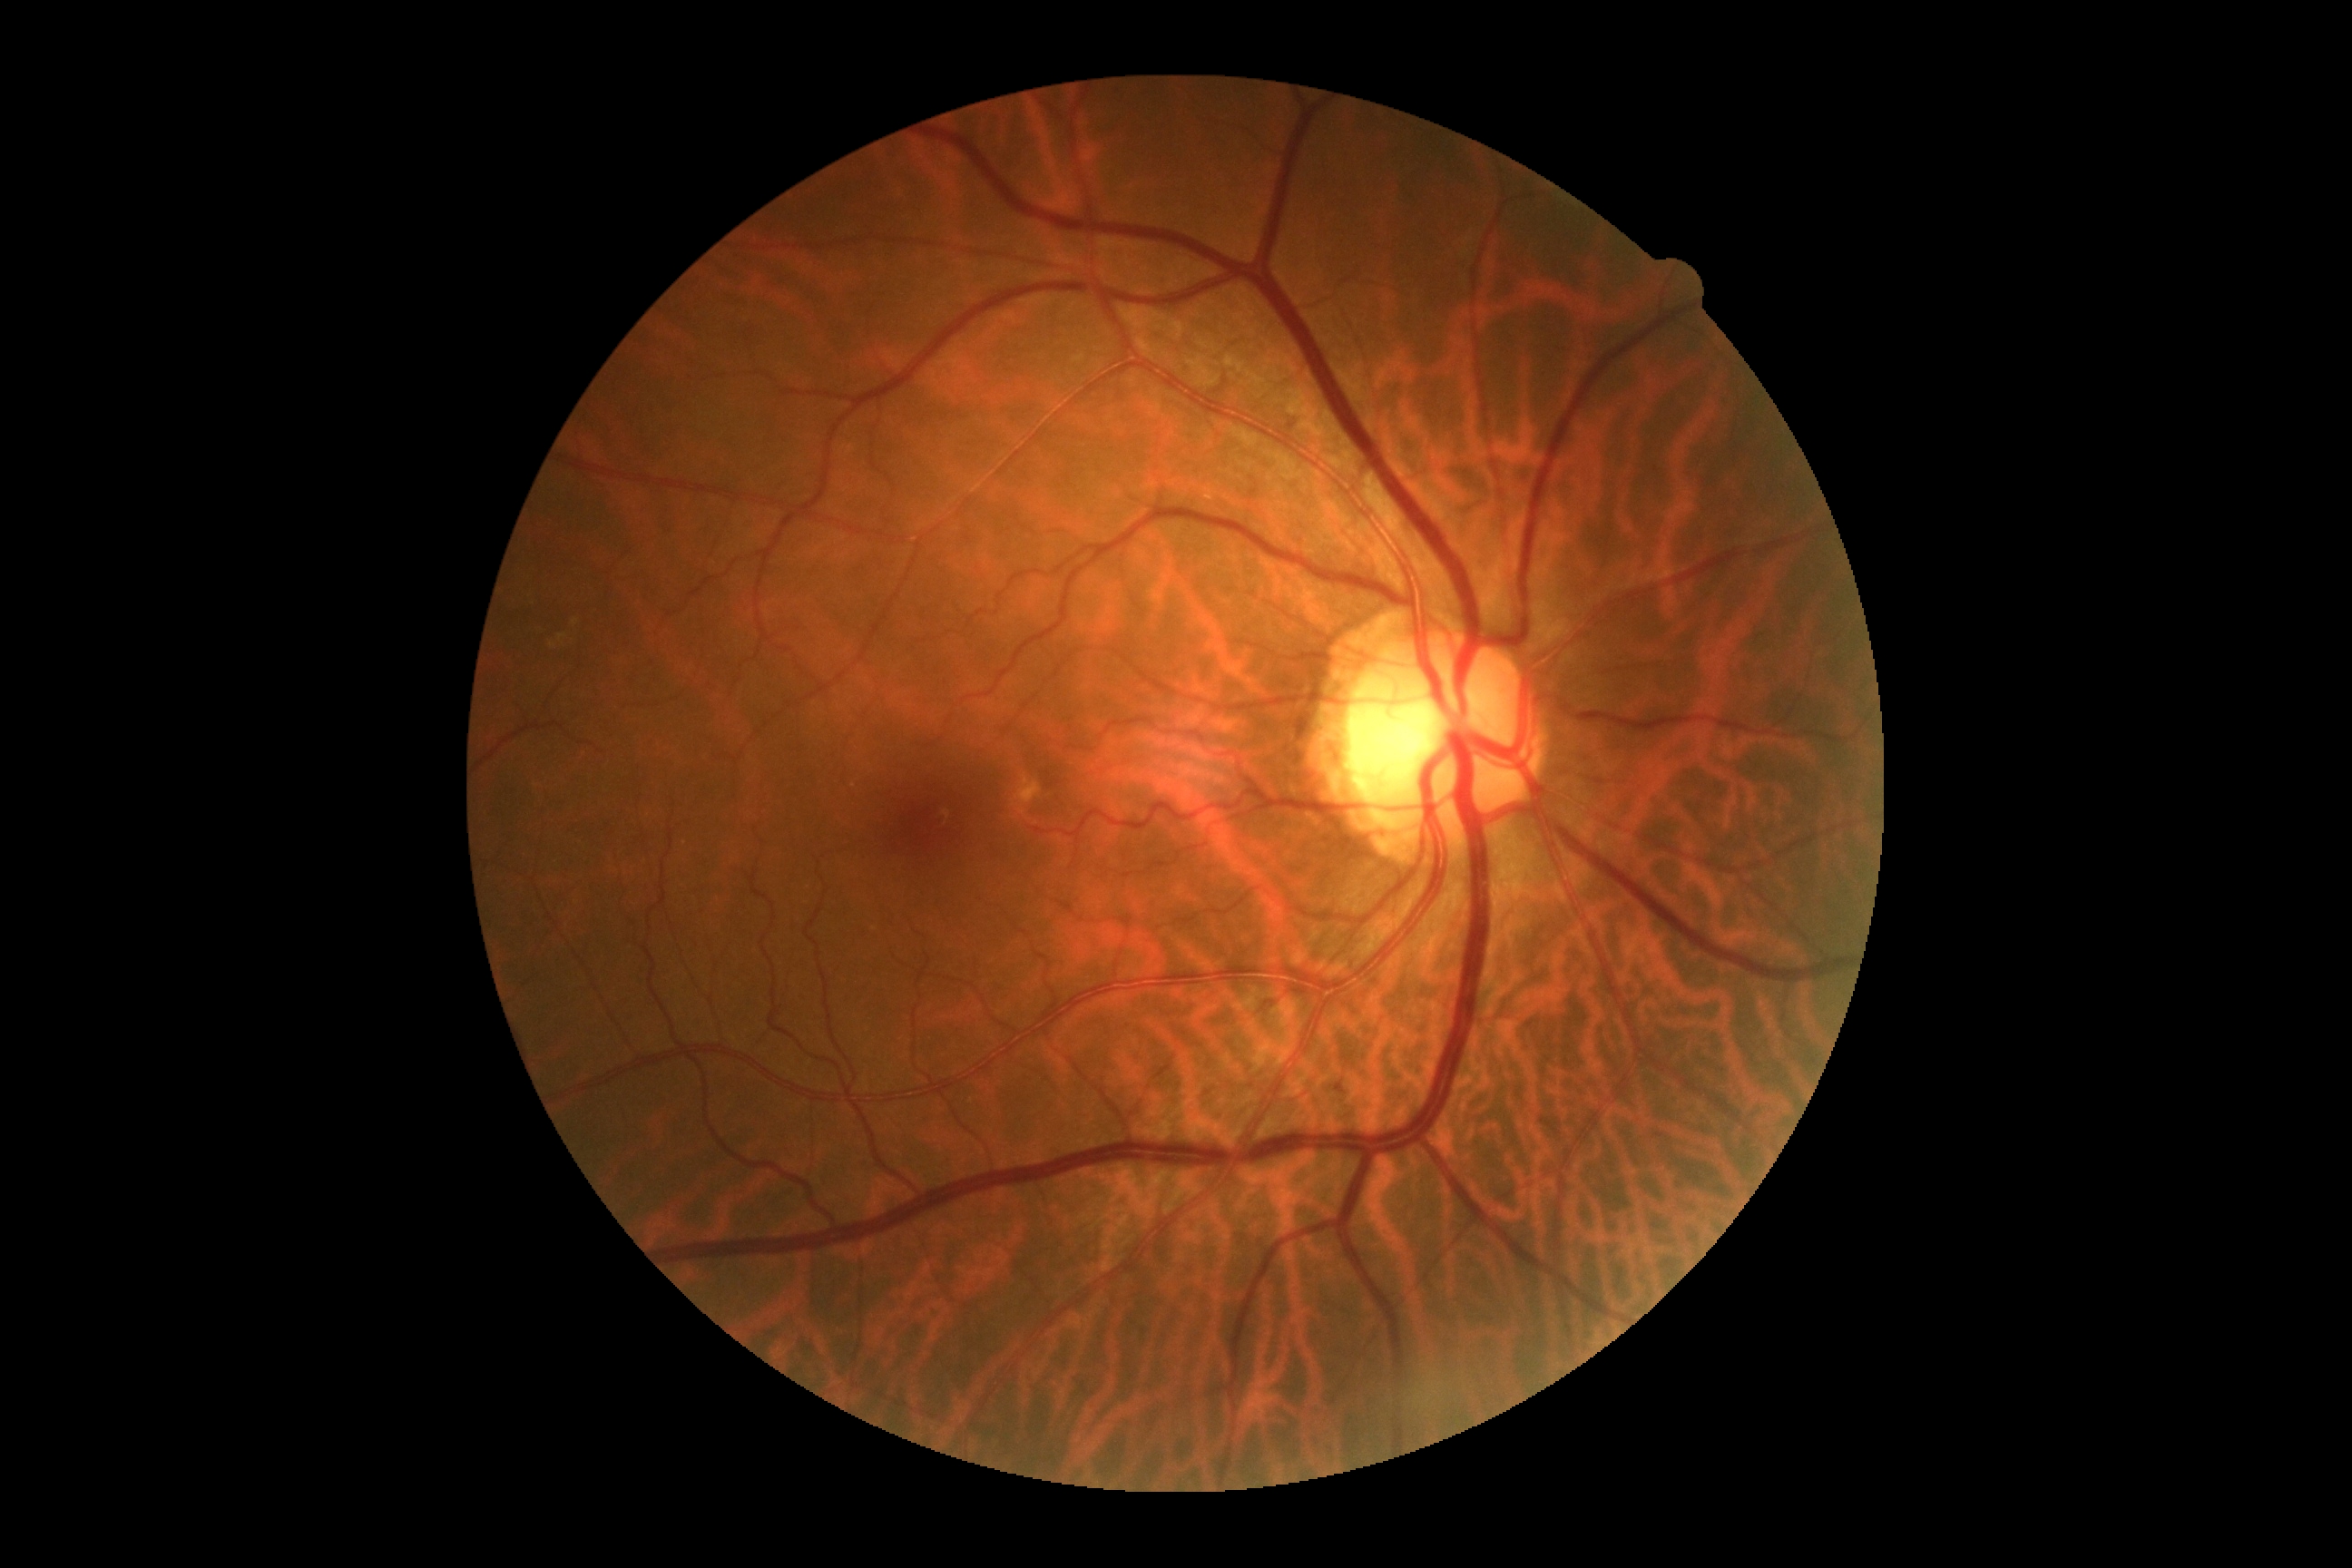   dr_grade: 0